45 degree fundus photograph
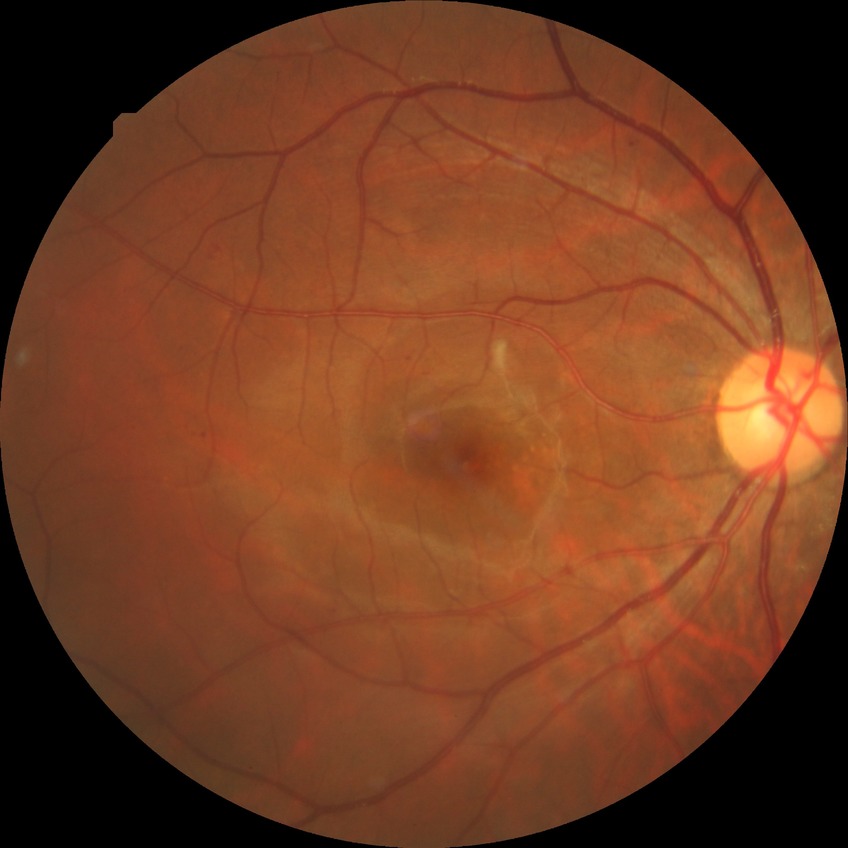 Diabetic retinopathy (DR): SDR (simple diabetic retinopathy).